Non-mydriatic
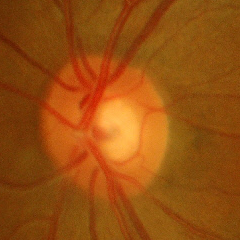
Q: Is glaucoma present?
A: No glaucoma.